CFP; 45-degree field of view.
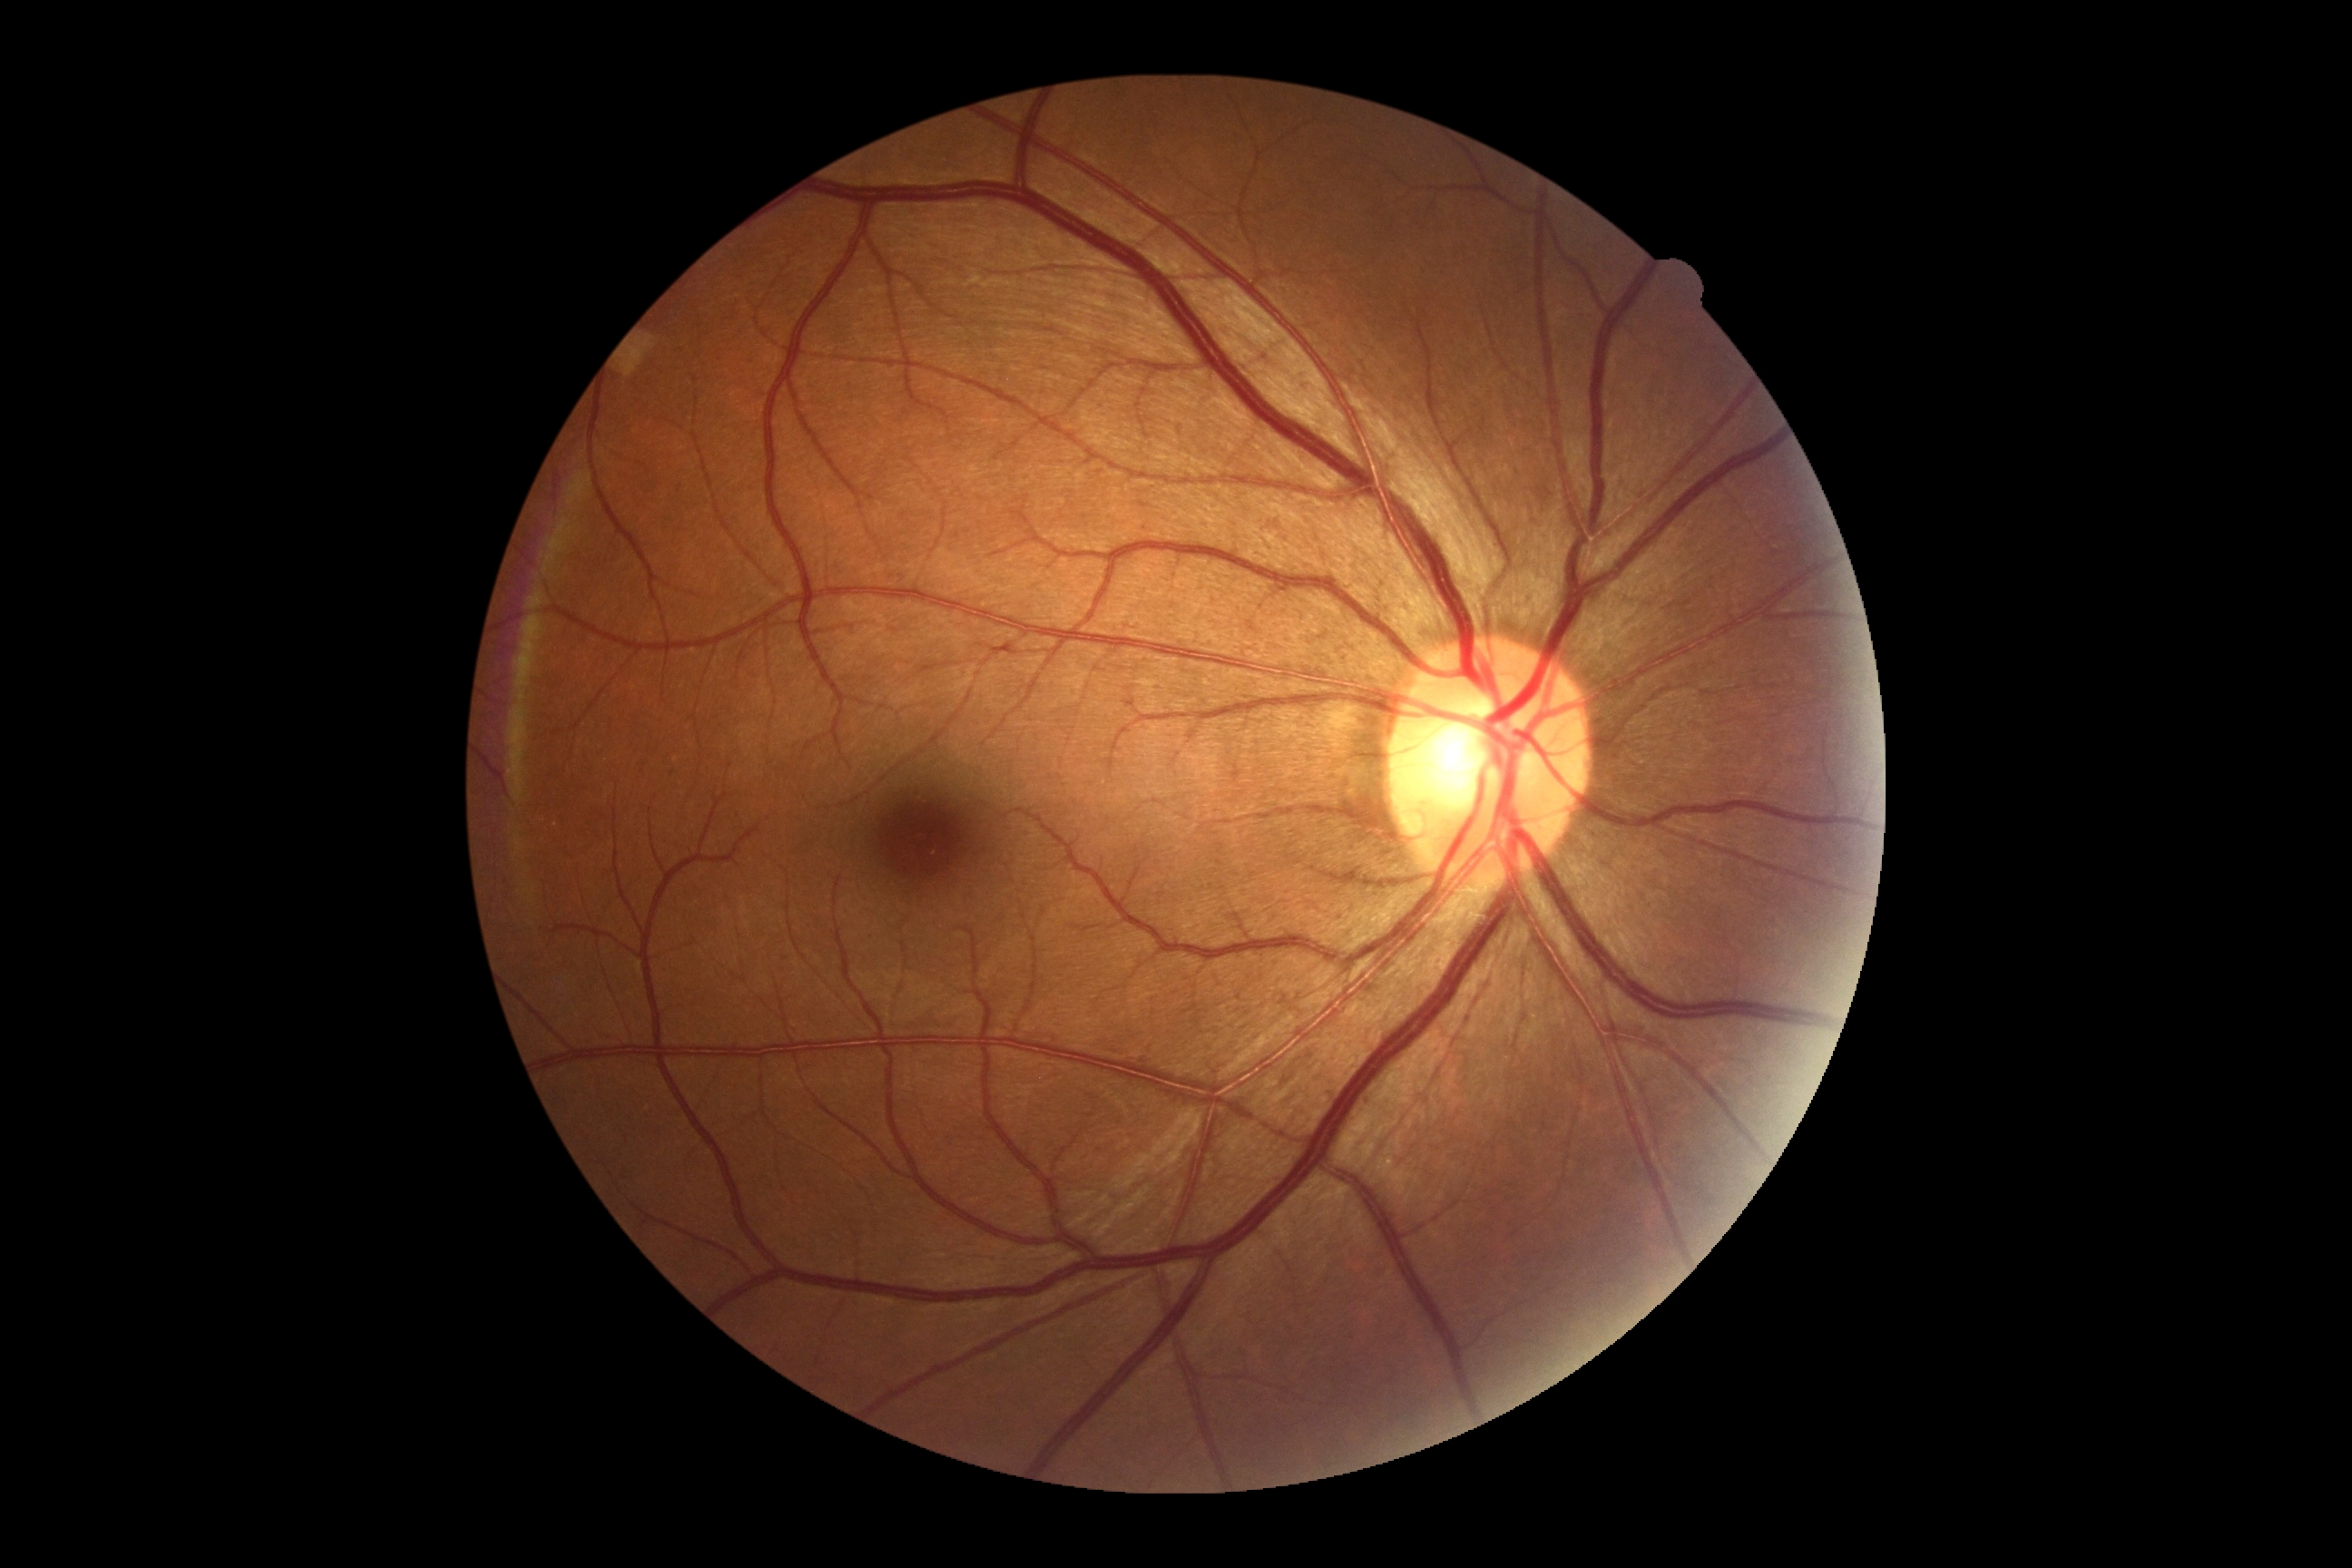
Retinopathy grade: 0.
No diabetic retinal disease findings.